Camera: NIDEK AFC-230 · 848 by 848 pixels.
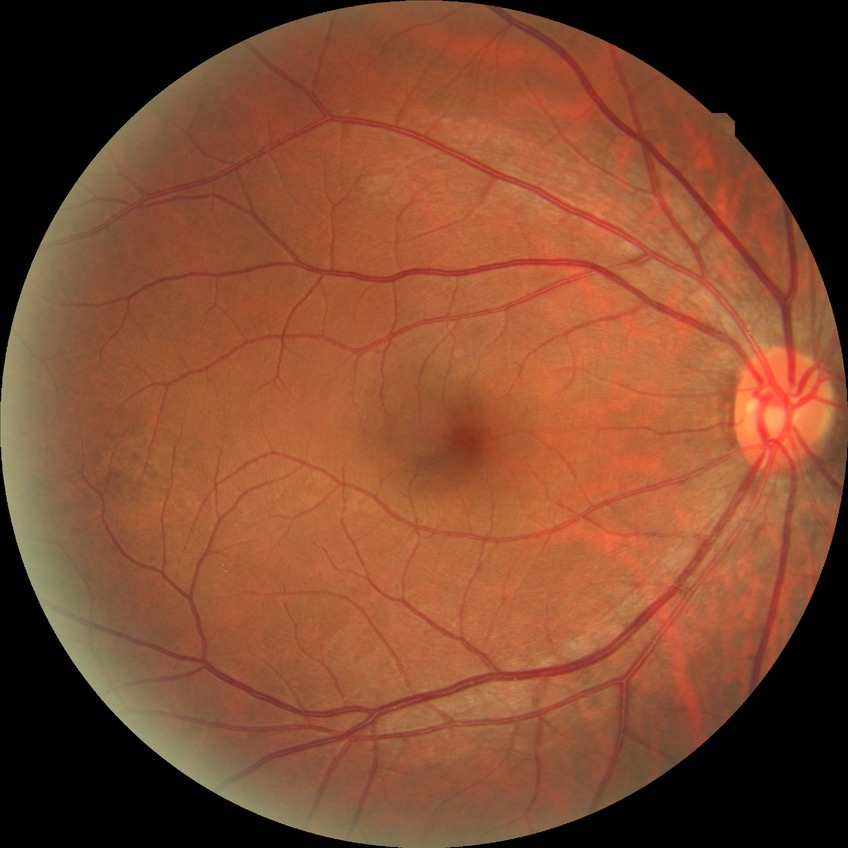 Diabetic retinopathy (DR) is no diabetic retinopathy (NDR).